512x512, fundus photo
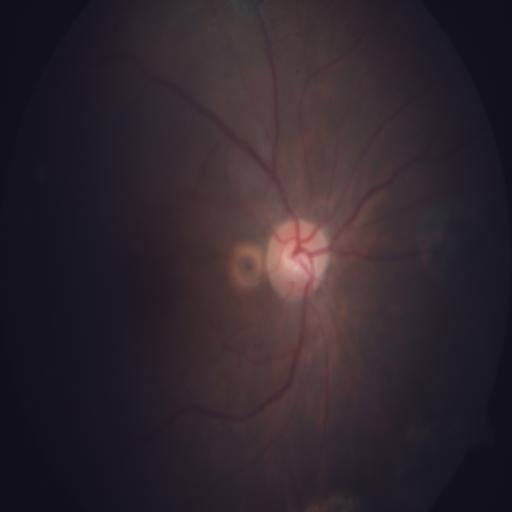
Findings consistent with optic disc pallor (ODP).